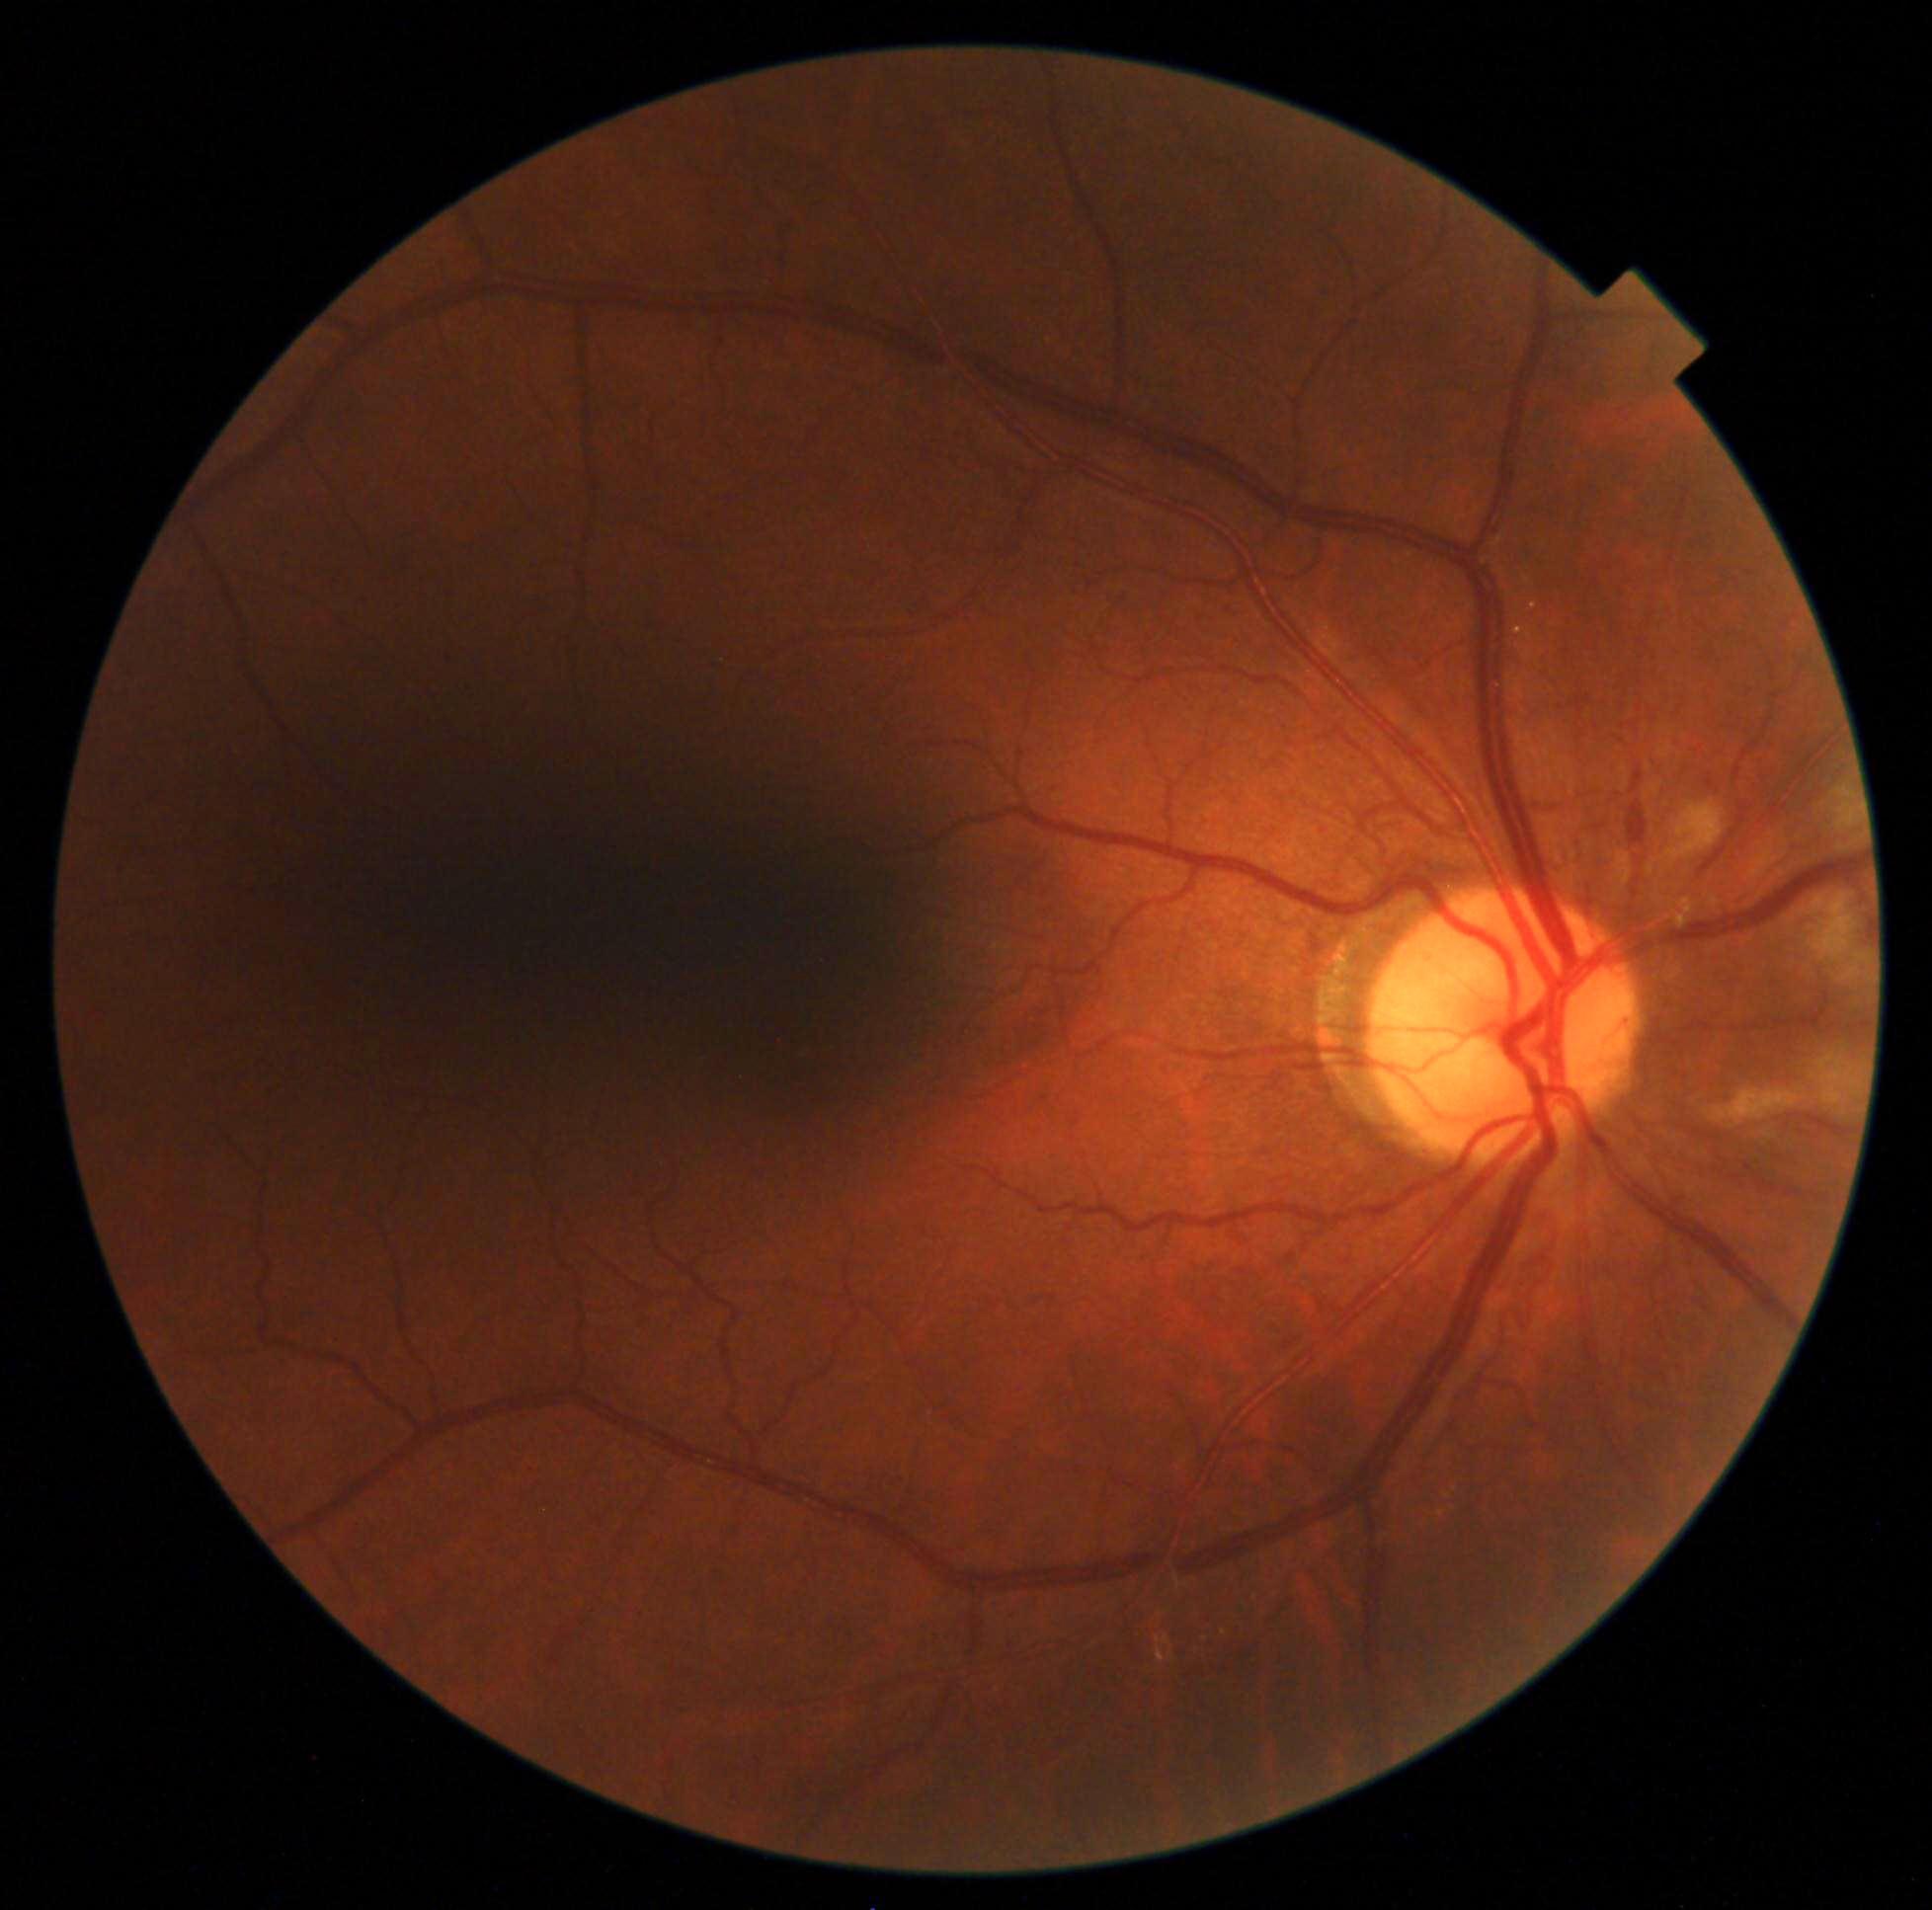
retinopathy = 2 — more than just microaneurysms but less than severe NPDR.